2352x1568px, 45° FOV, CFP: 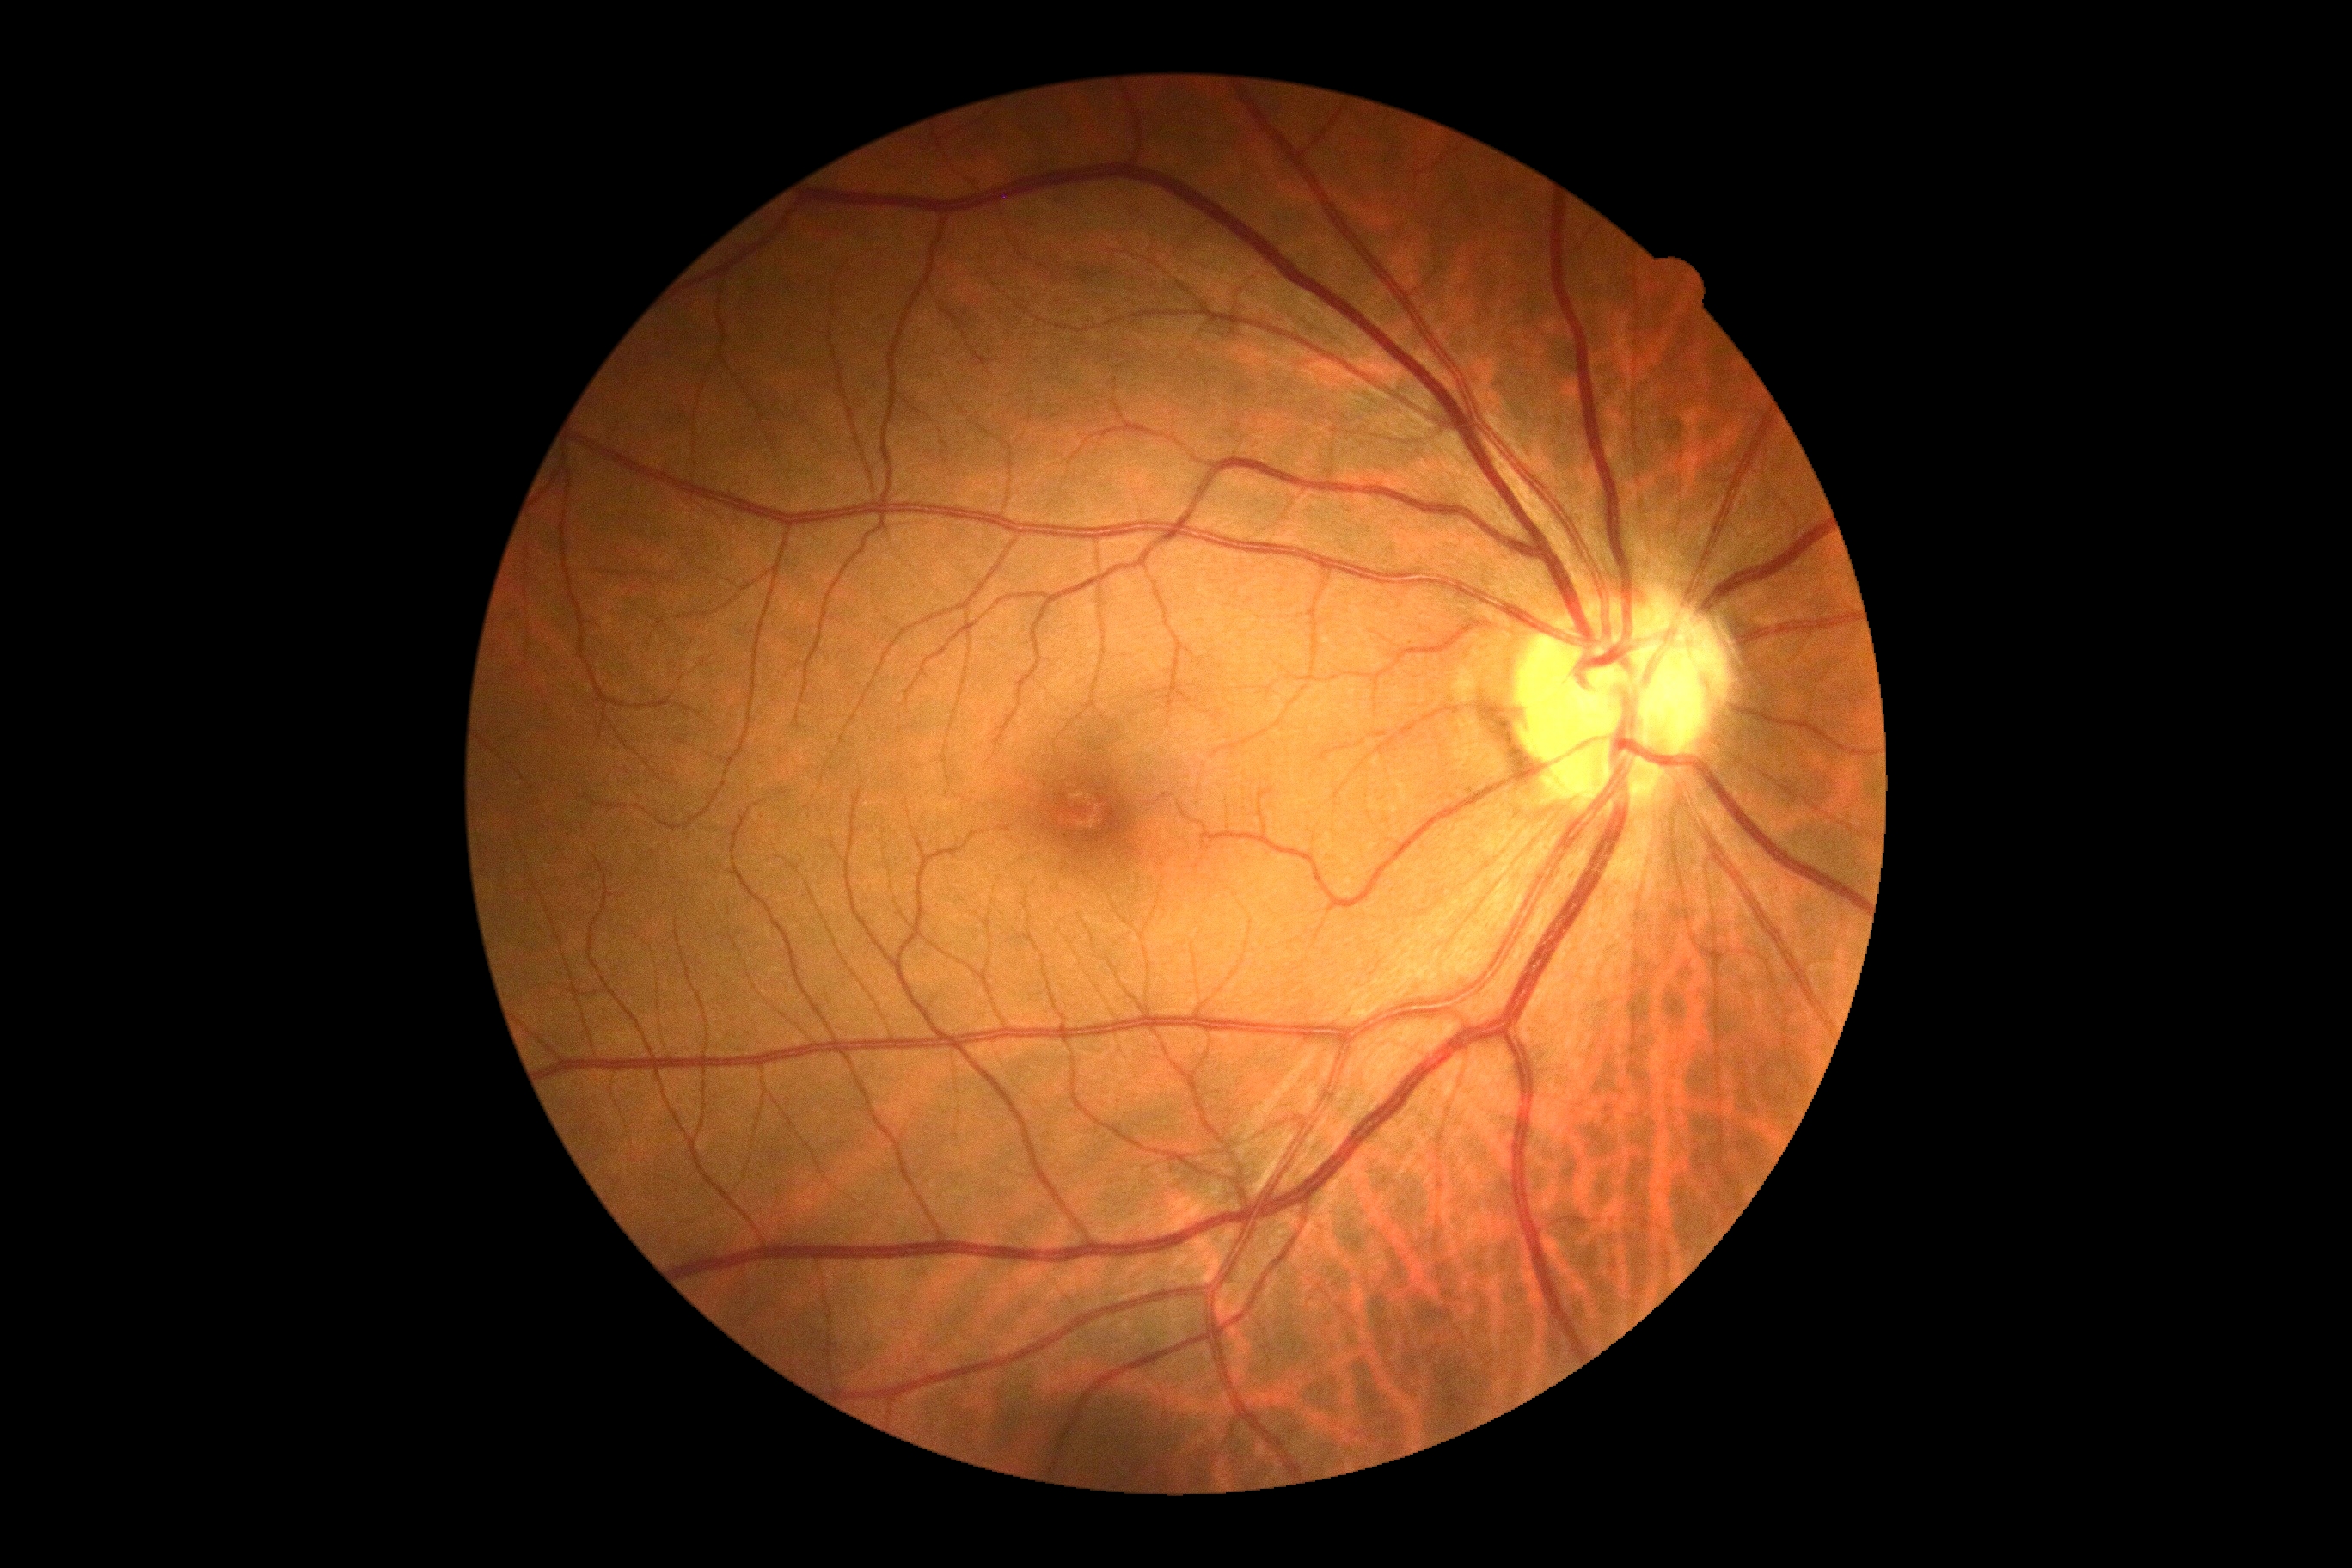 DR impression=no apparent DR, DR=no apparent retinopathy (grade 0).